Captured with the Phoenix ICON (100° field of view); wide-field contact fundus photograph of an infant.
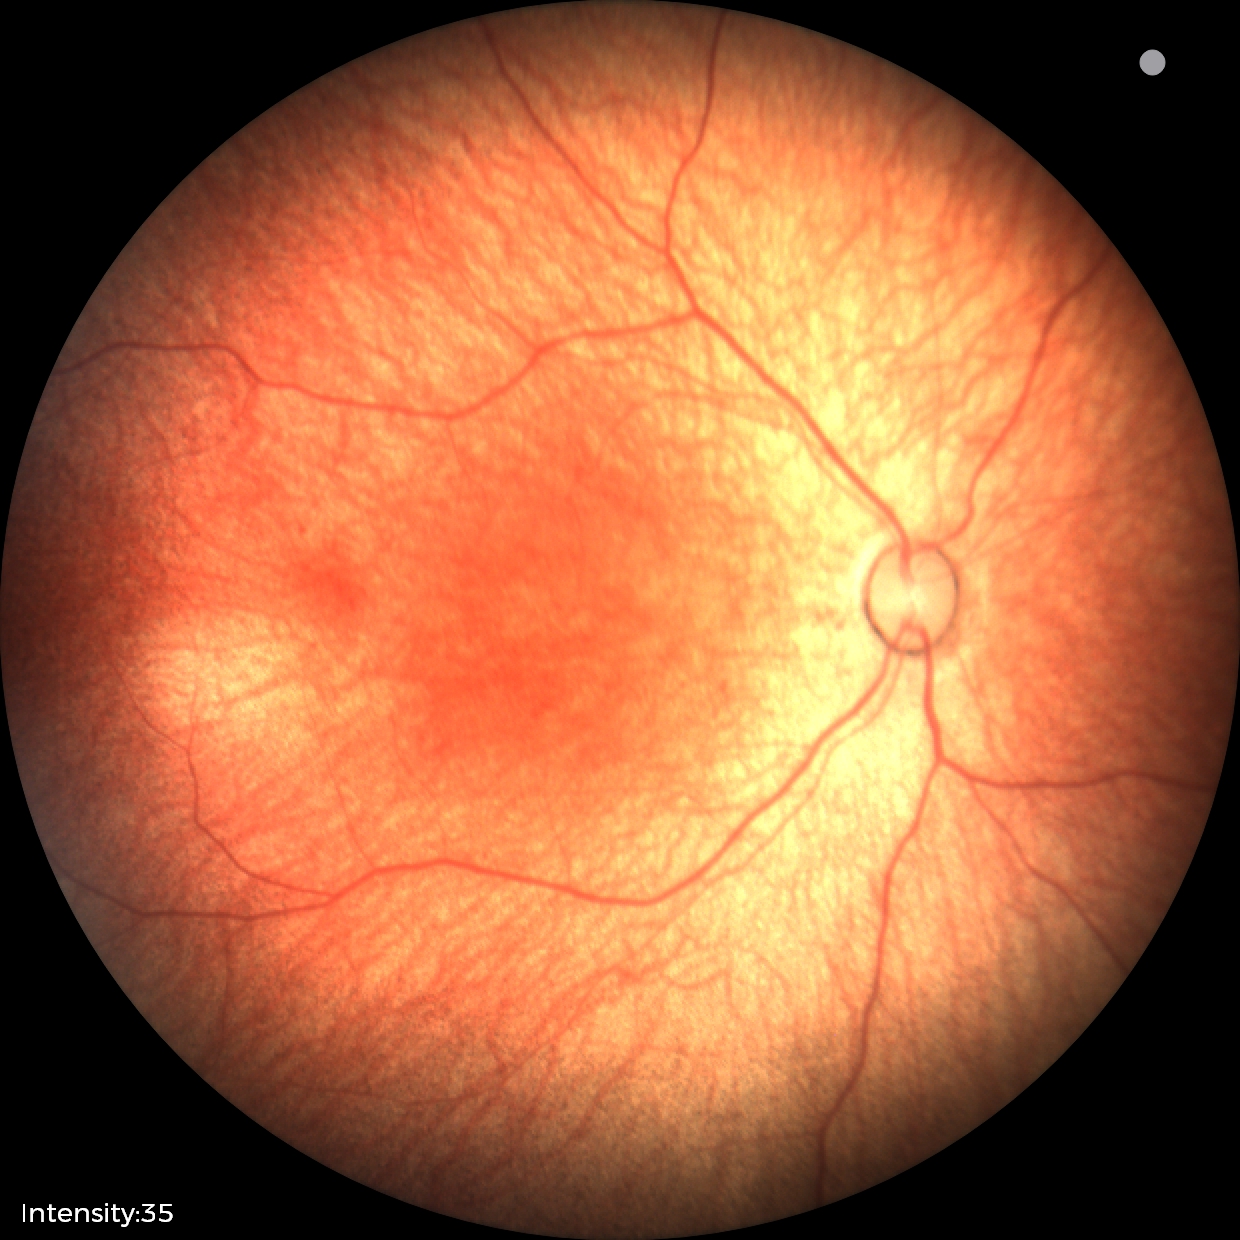 Examination with physiological retinal findings.